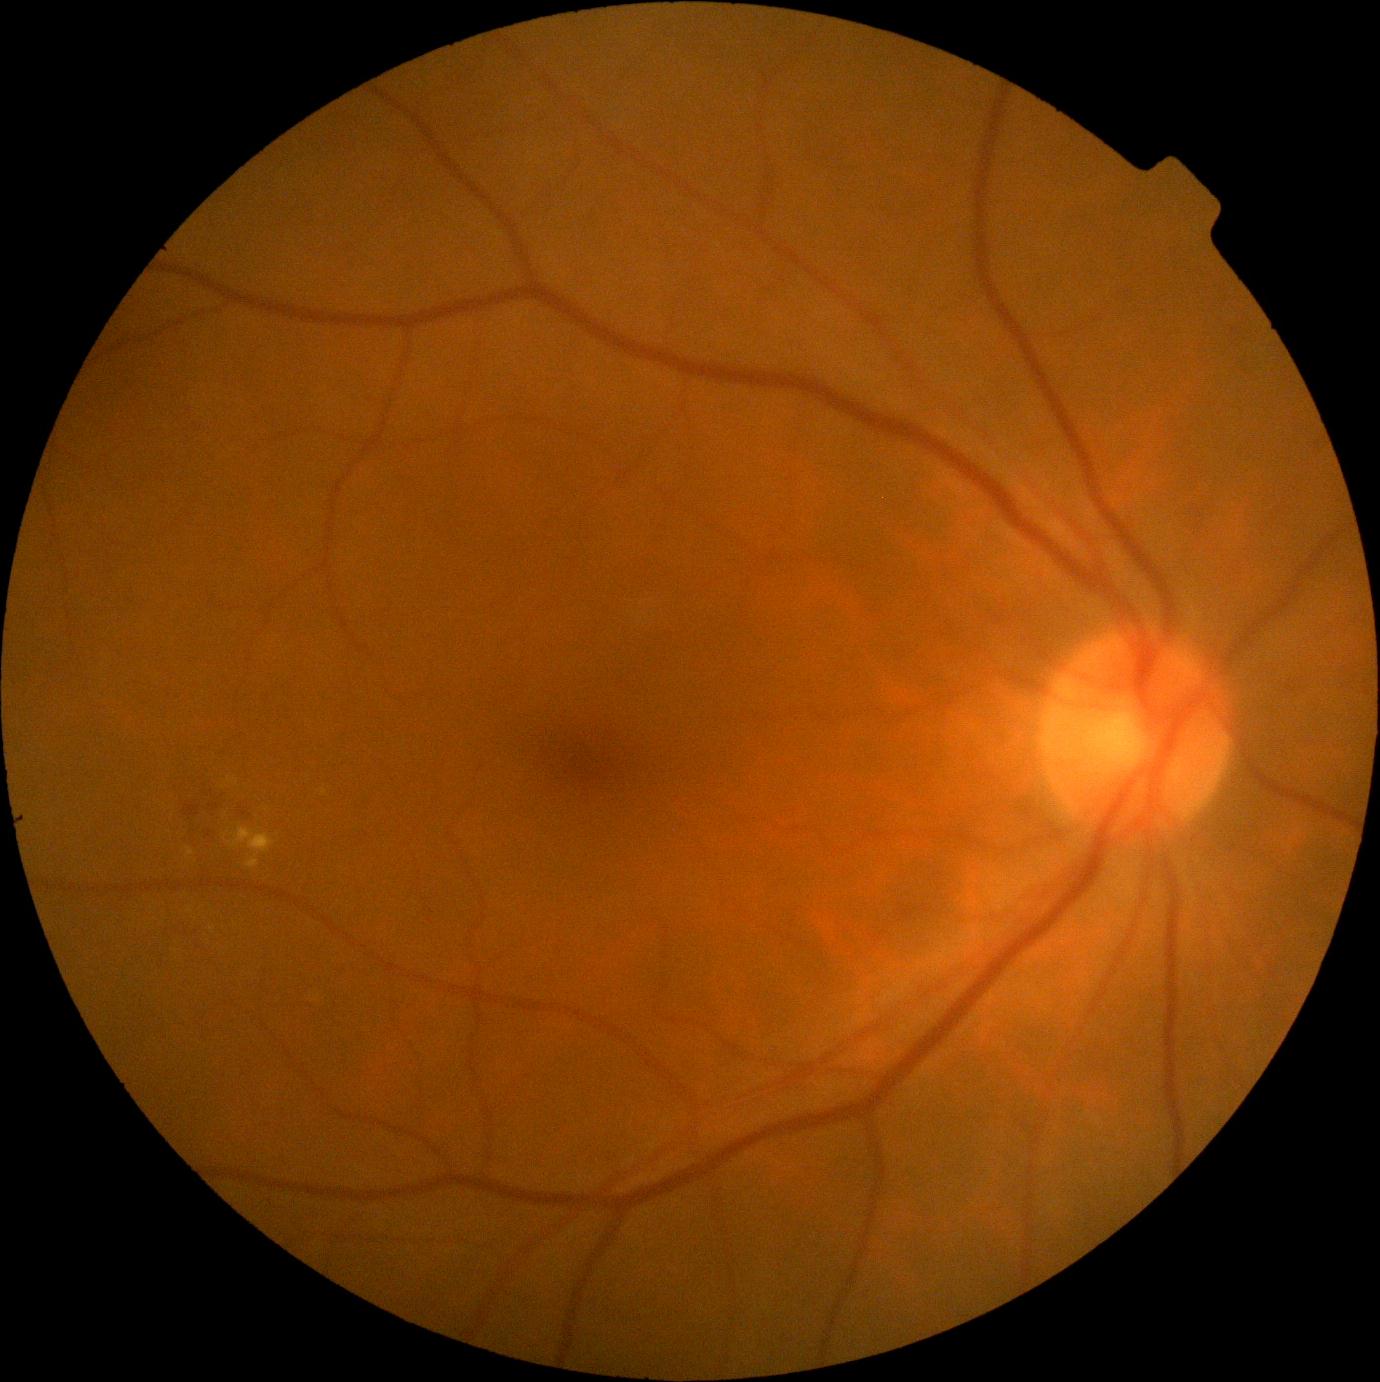 <lesions partial="true">
  <dr_grade>2</dr_grade>
  <ex partial="true">region(187, 848, 195, 859), region(233, 827, 276, 870)</ex>
  <ex_small>(237, 780), (230, 780), (224, 788), (324, 792)</ex_small>
  <he>region(231, 800, 256, 823), region(184, 805, 200, 817), region(209, 785, 217, 798), region(207, 800, 222, 819)</he>
  <se />
  <ma />
</lesions>